640 x 480 pixels; acquired on the Clarity RetCam 3; wide-field fundus photograph of an infant:
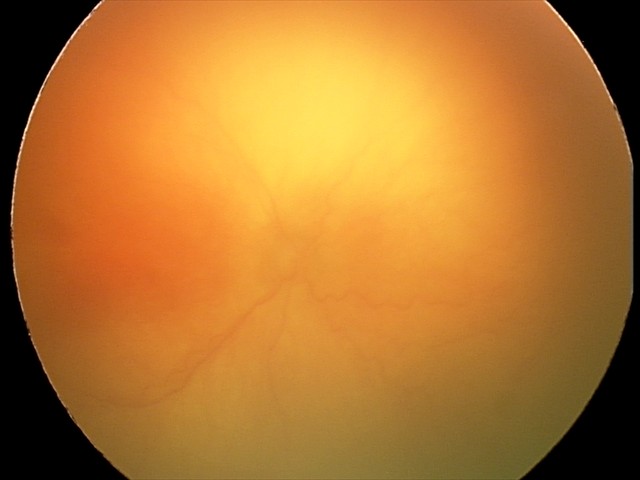 From an examination with diagnosis of aggressive retinopathy of prematurity.